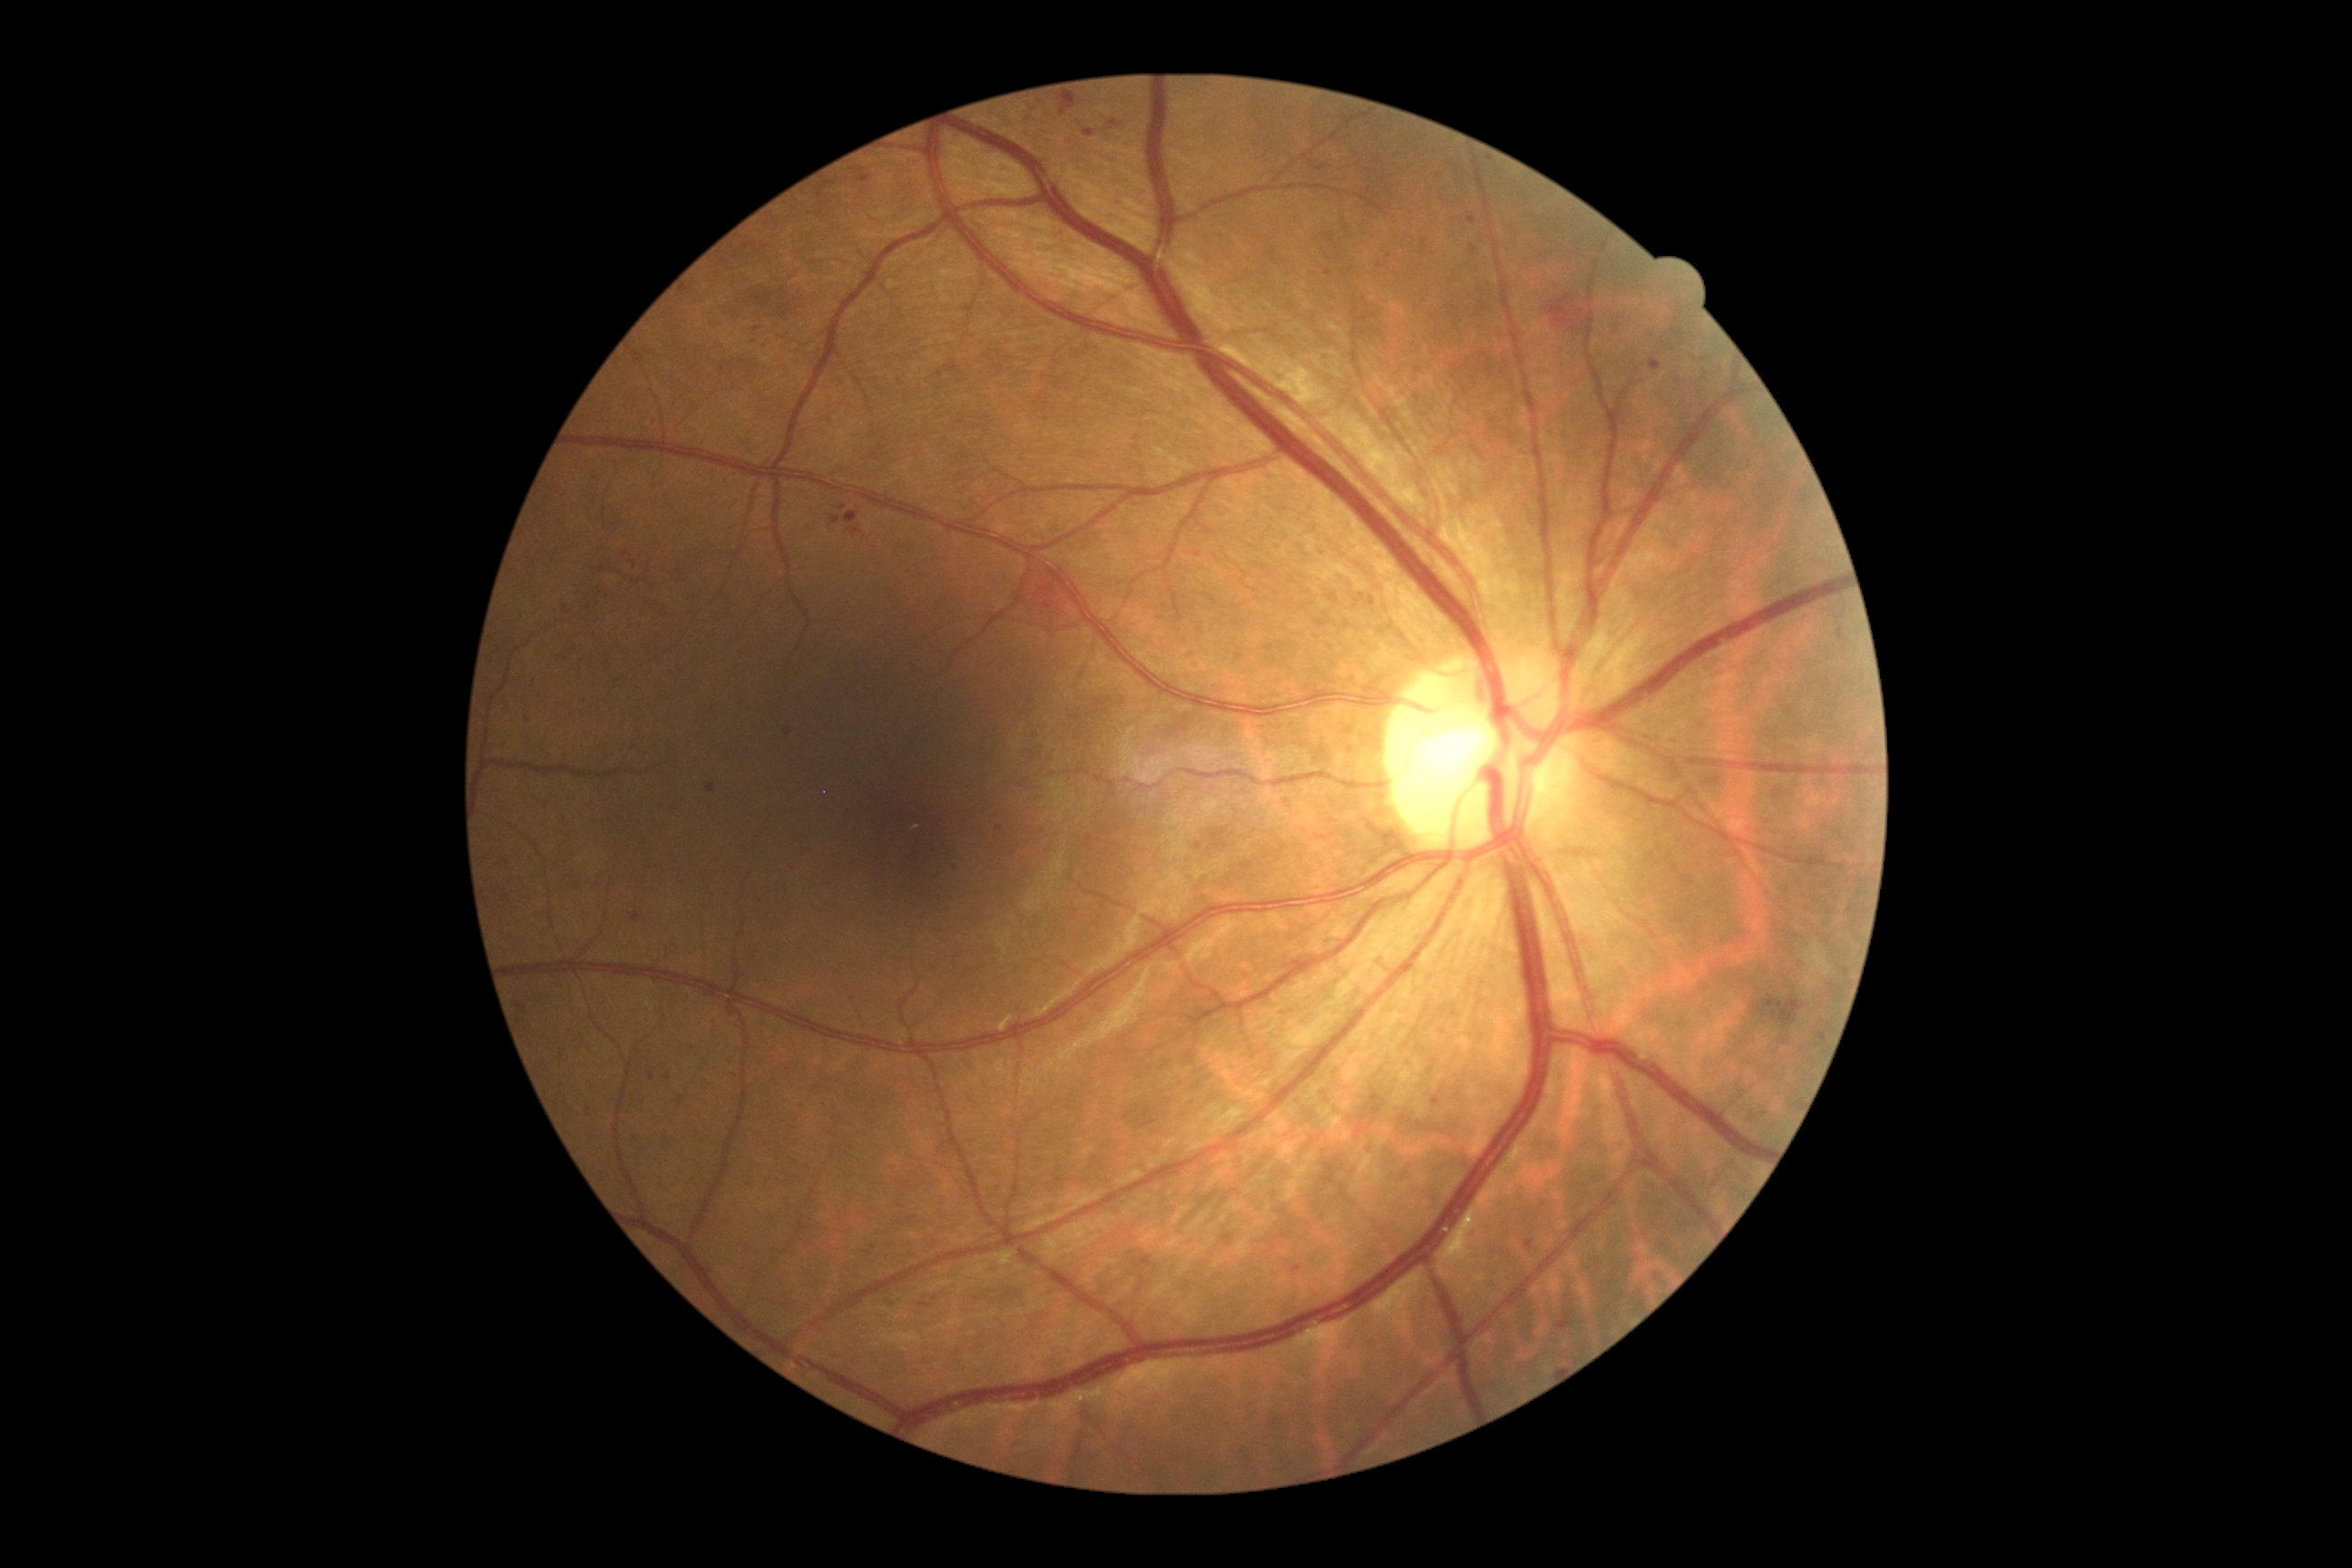 DR is moderate non-proliferative diabetic retinopathy (grade 2) — more than just microaneurysms but less than severe NPDR.